Non-mydriatic acquisition: 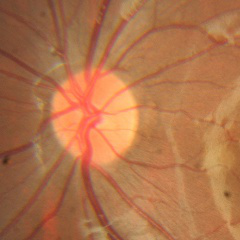

No glaucoma.